130° field of view (Natus RetCam Envision) · image size 1440x1080 · wide-field fundus photograph of an infant: 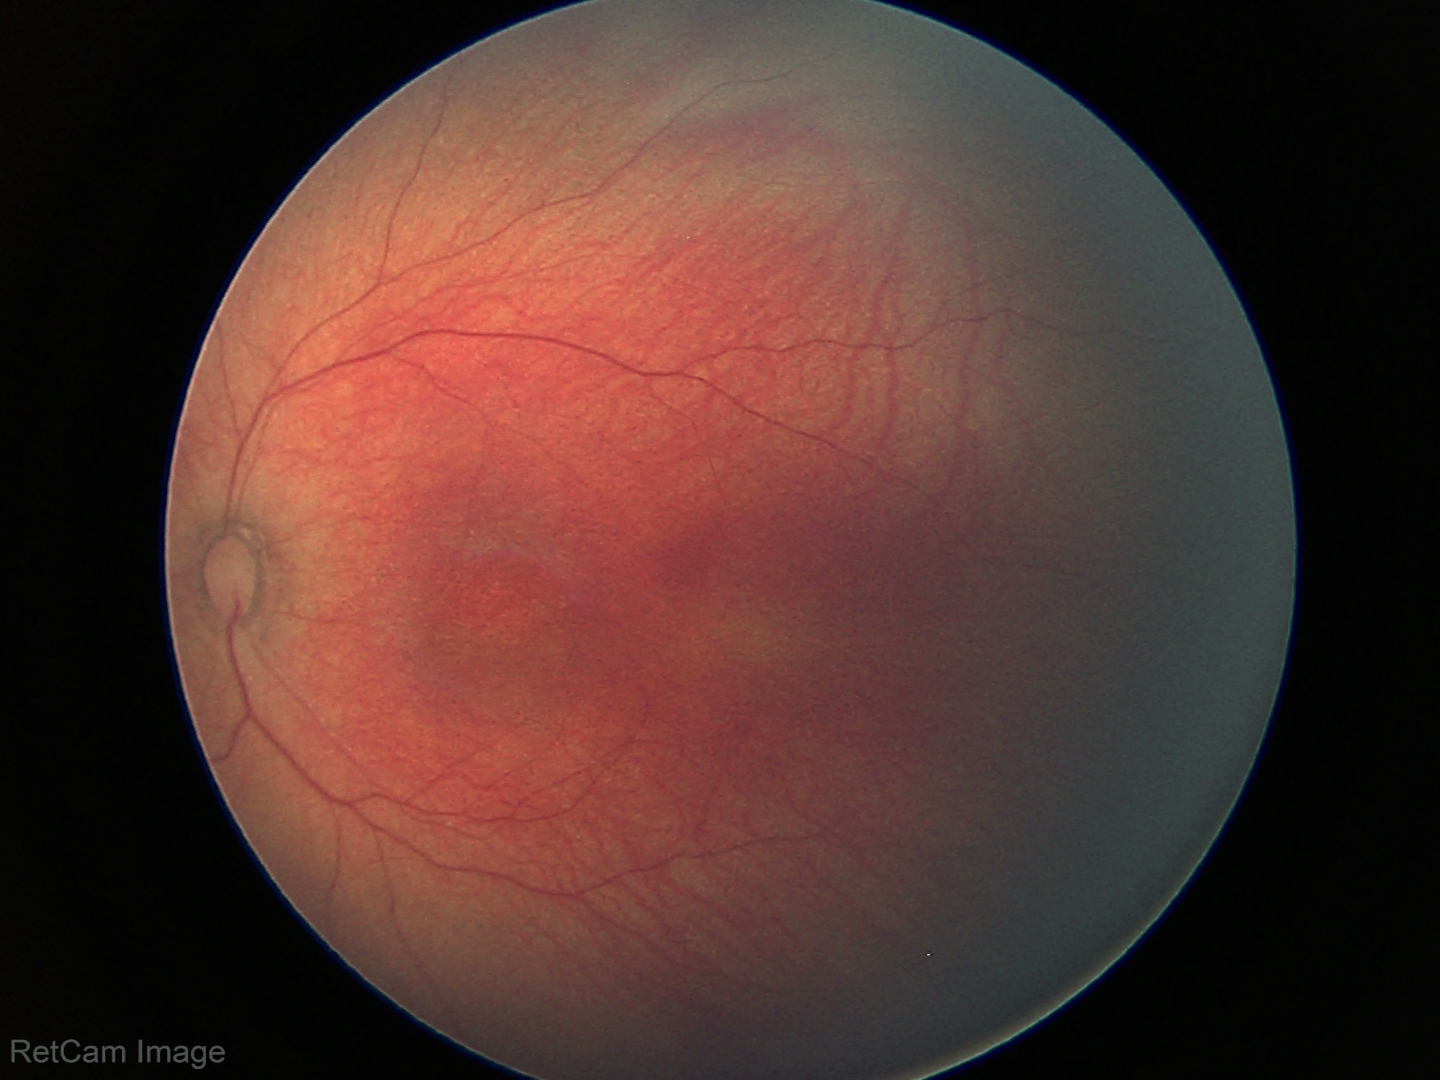 Physiological retinal appearance for postconceptual age.